Infant wide-field retinal image. 130° field of view (Clarity RetCam 3).
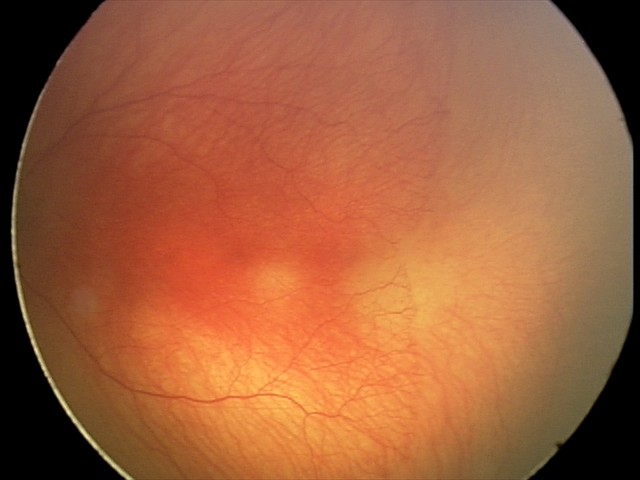
Plus form: present
assessment: A-ROP (aggressive ROP)